Camera: Topcon TRC-50DX
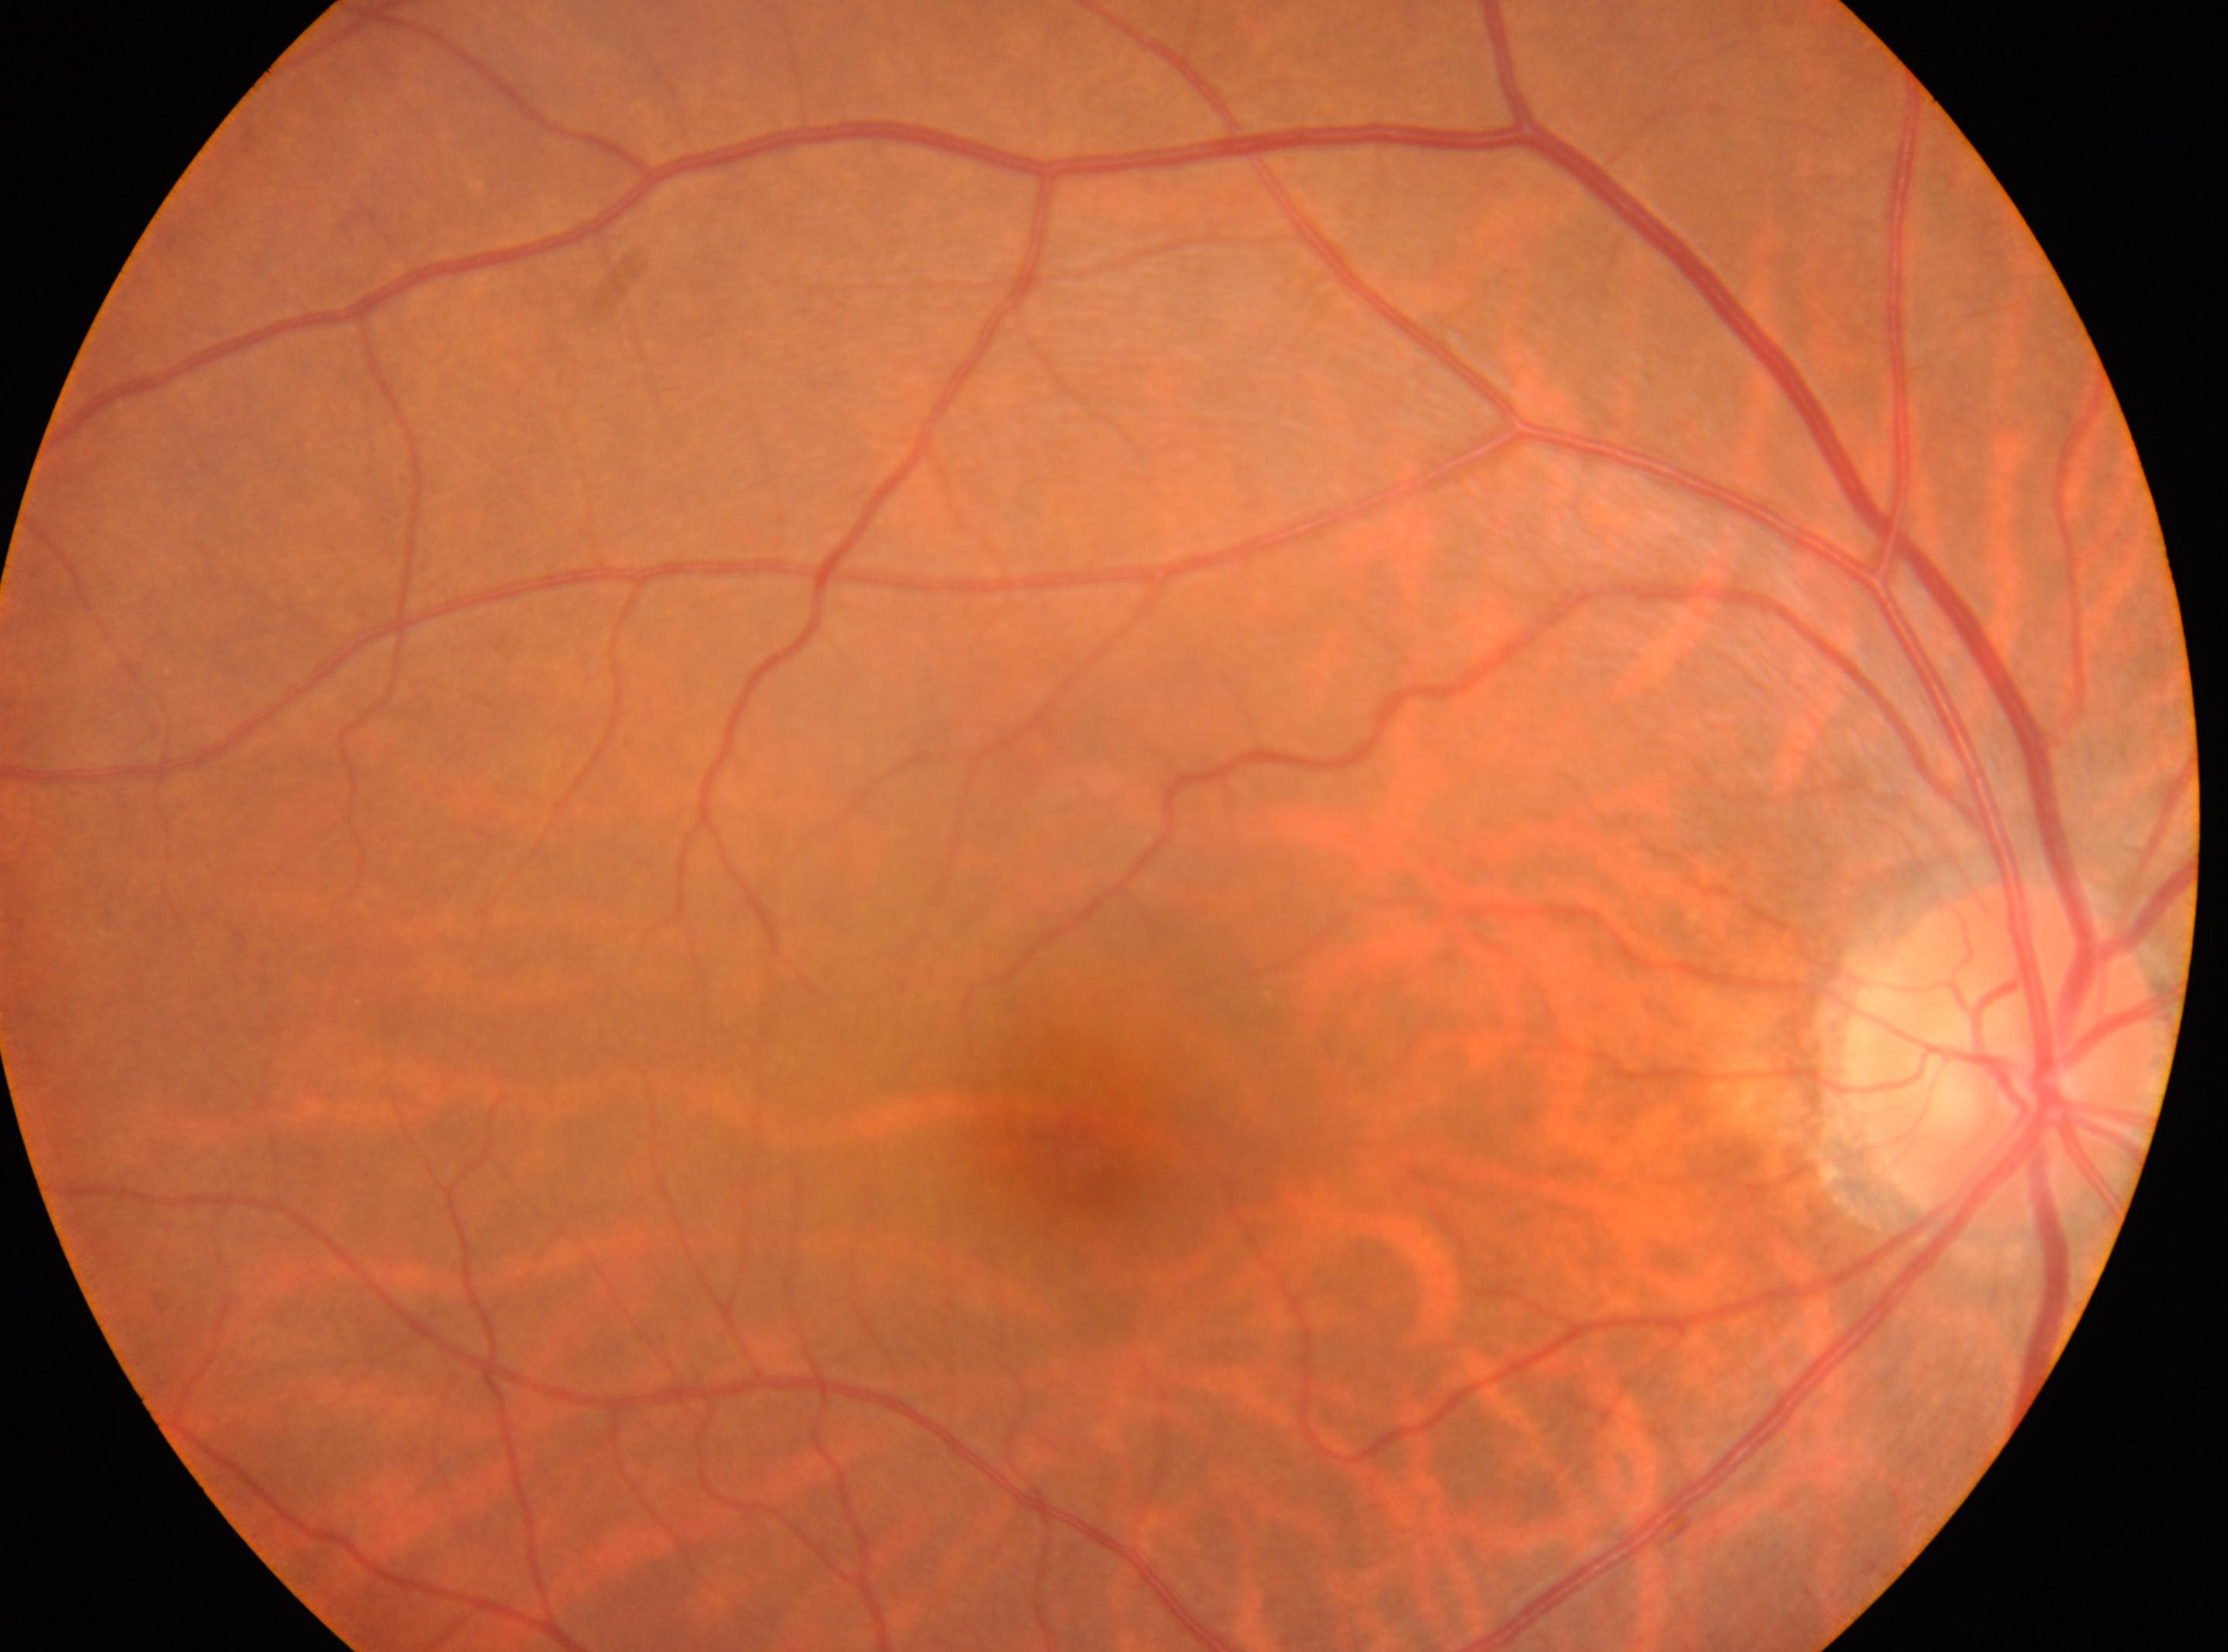
macula center: 1088, 1149 | DR: grade 0 (no apparent retinopathy) | optic disk: 1997, 1053 | DR impression: No apparent diabetic retinopathy | laterality: right eye.